Mydriatic (tropicamide phenylephrine 1.0%) · 50-degree field of view: 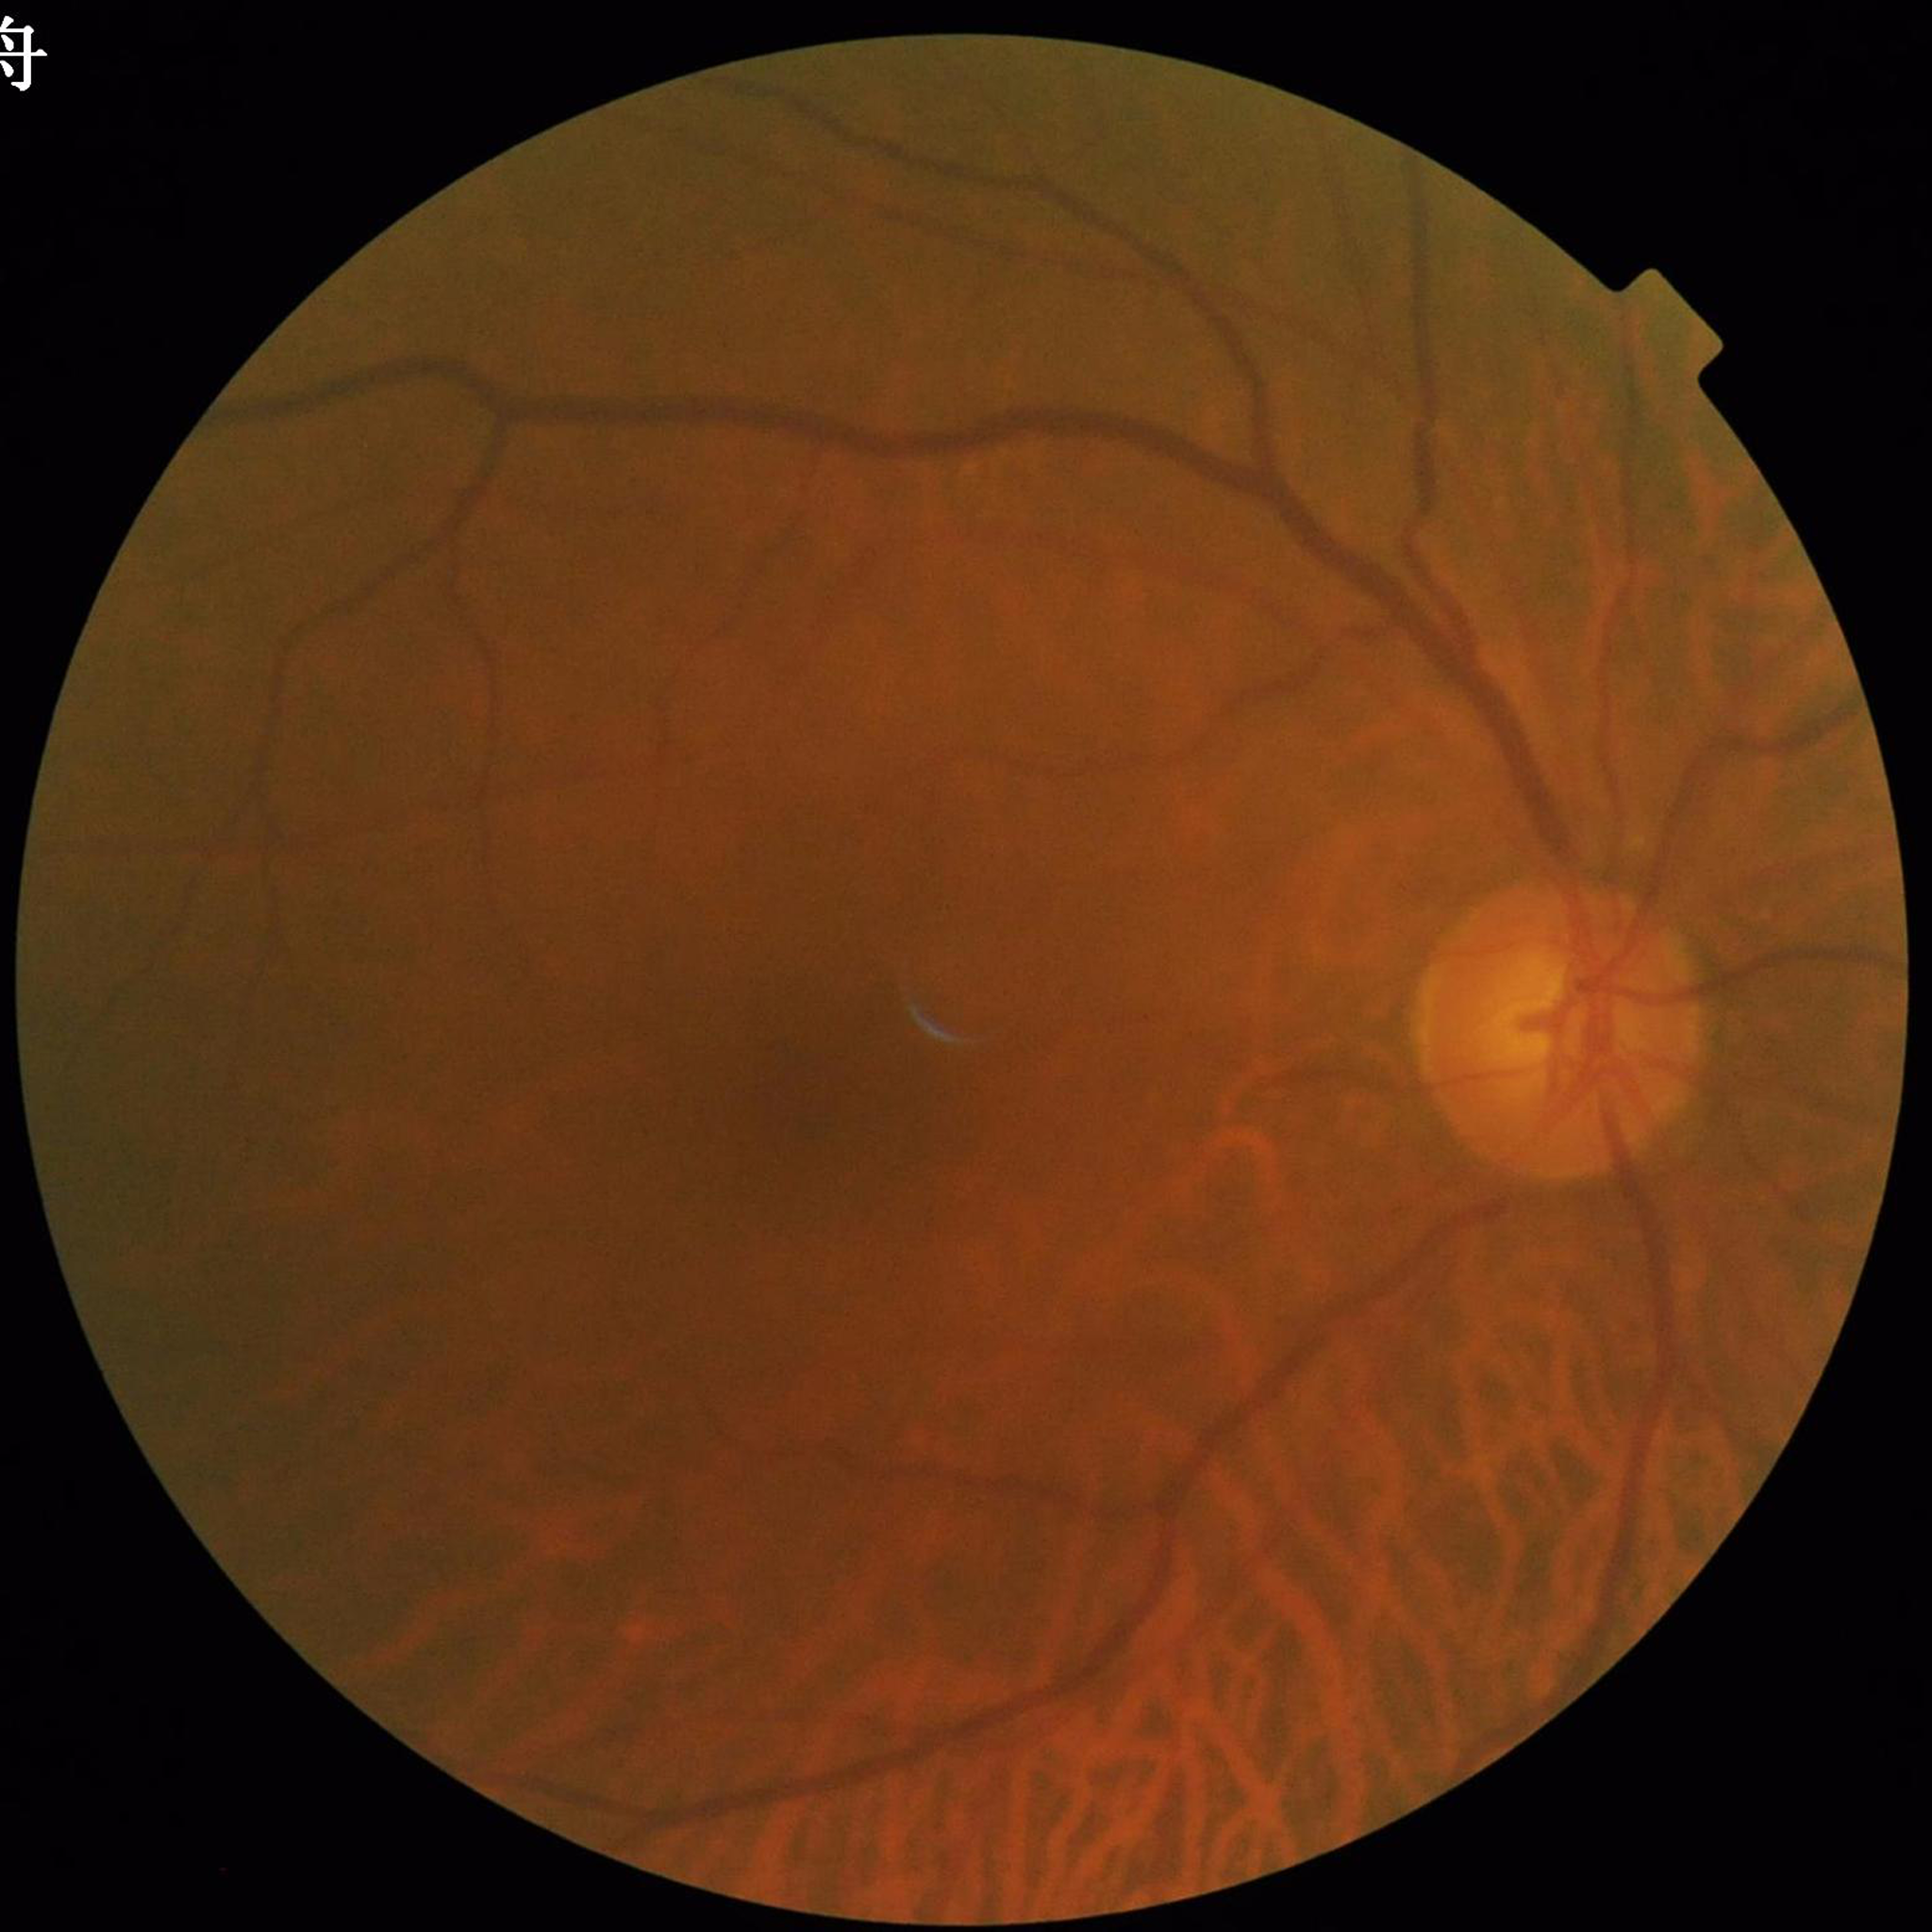

This fundus photograph is from a patient diagnosed with glaucoma.